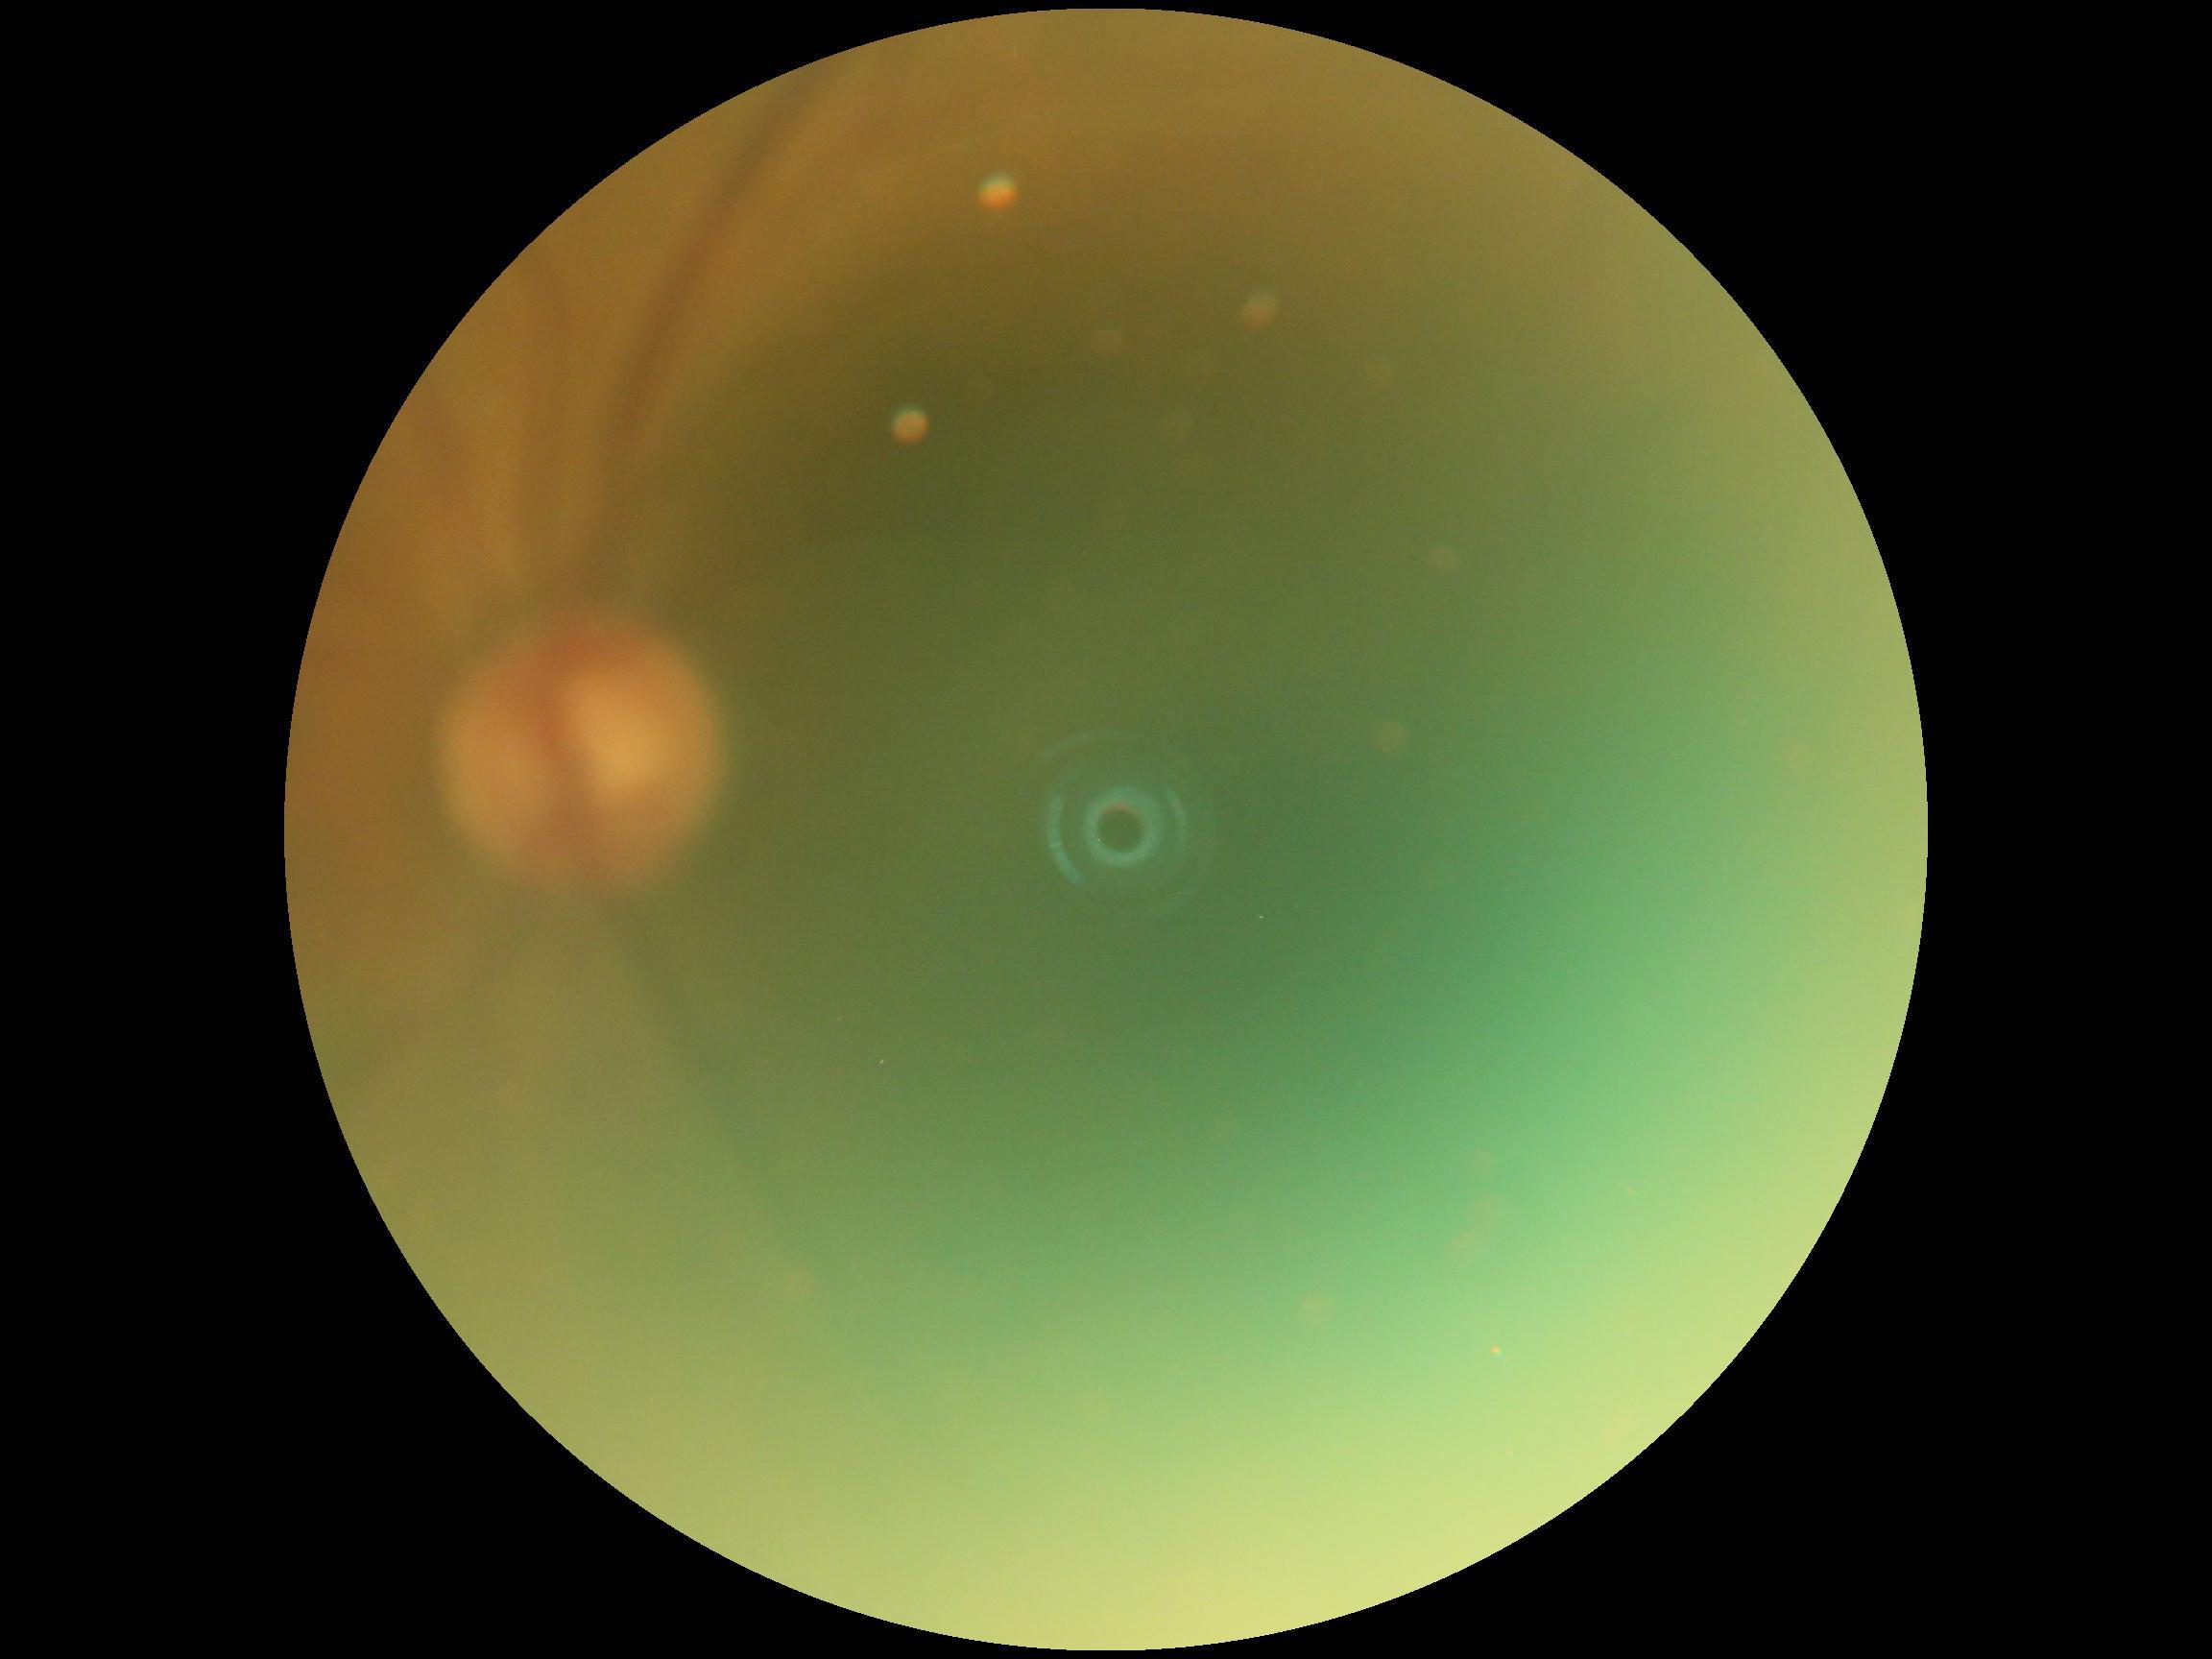
DR grade is ungradable.
Image quality is insufficient for diabetic retinopathy assessment.